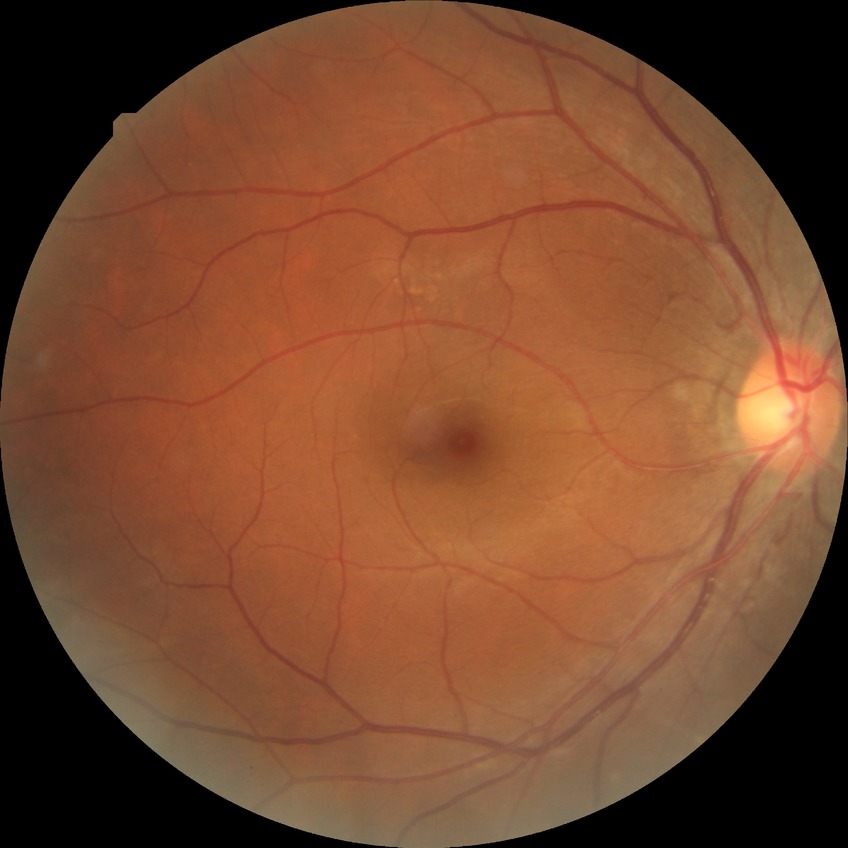
{"davis_grade": "NDR"}